Color fundus image.
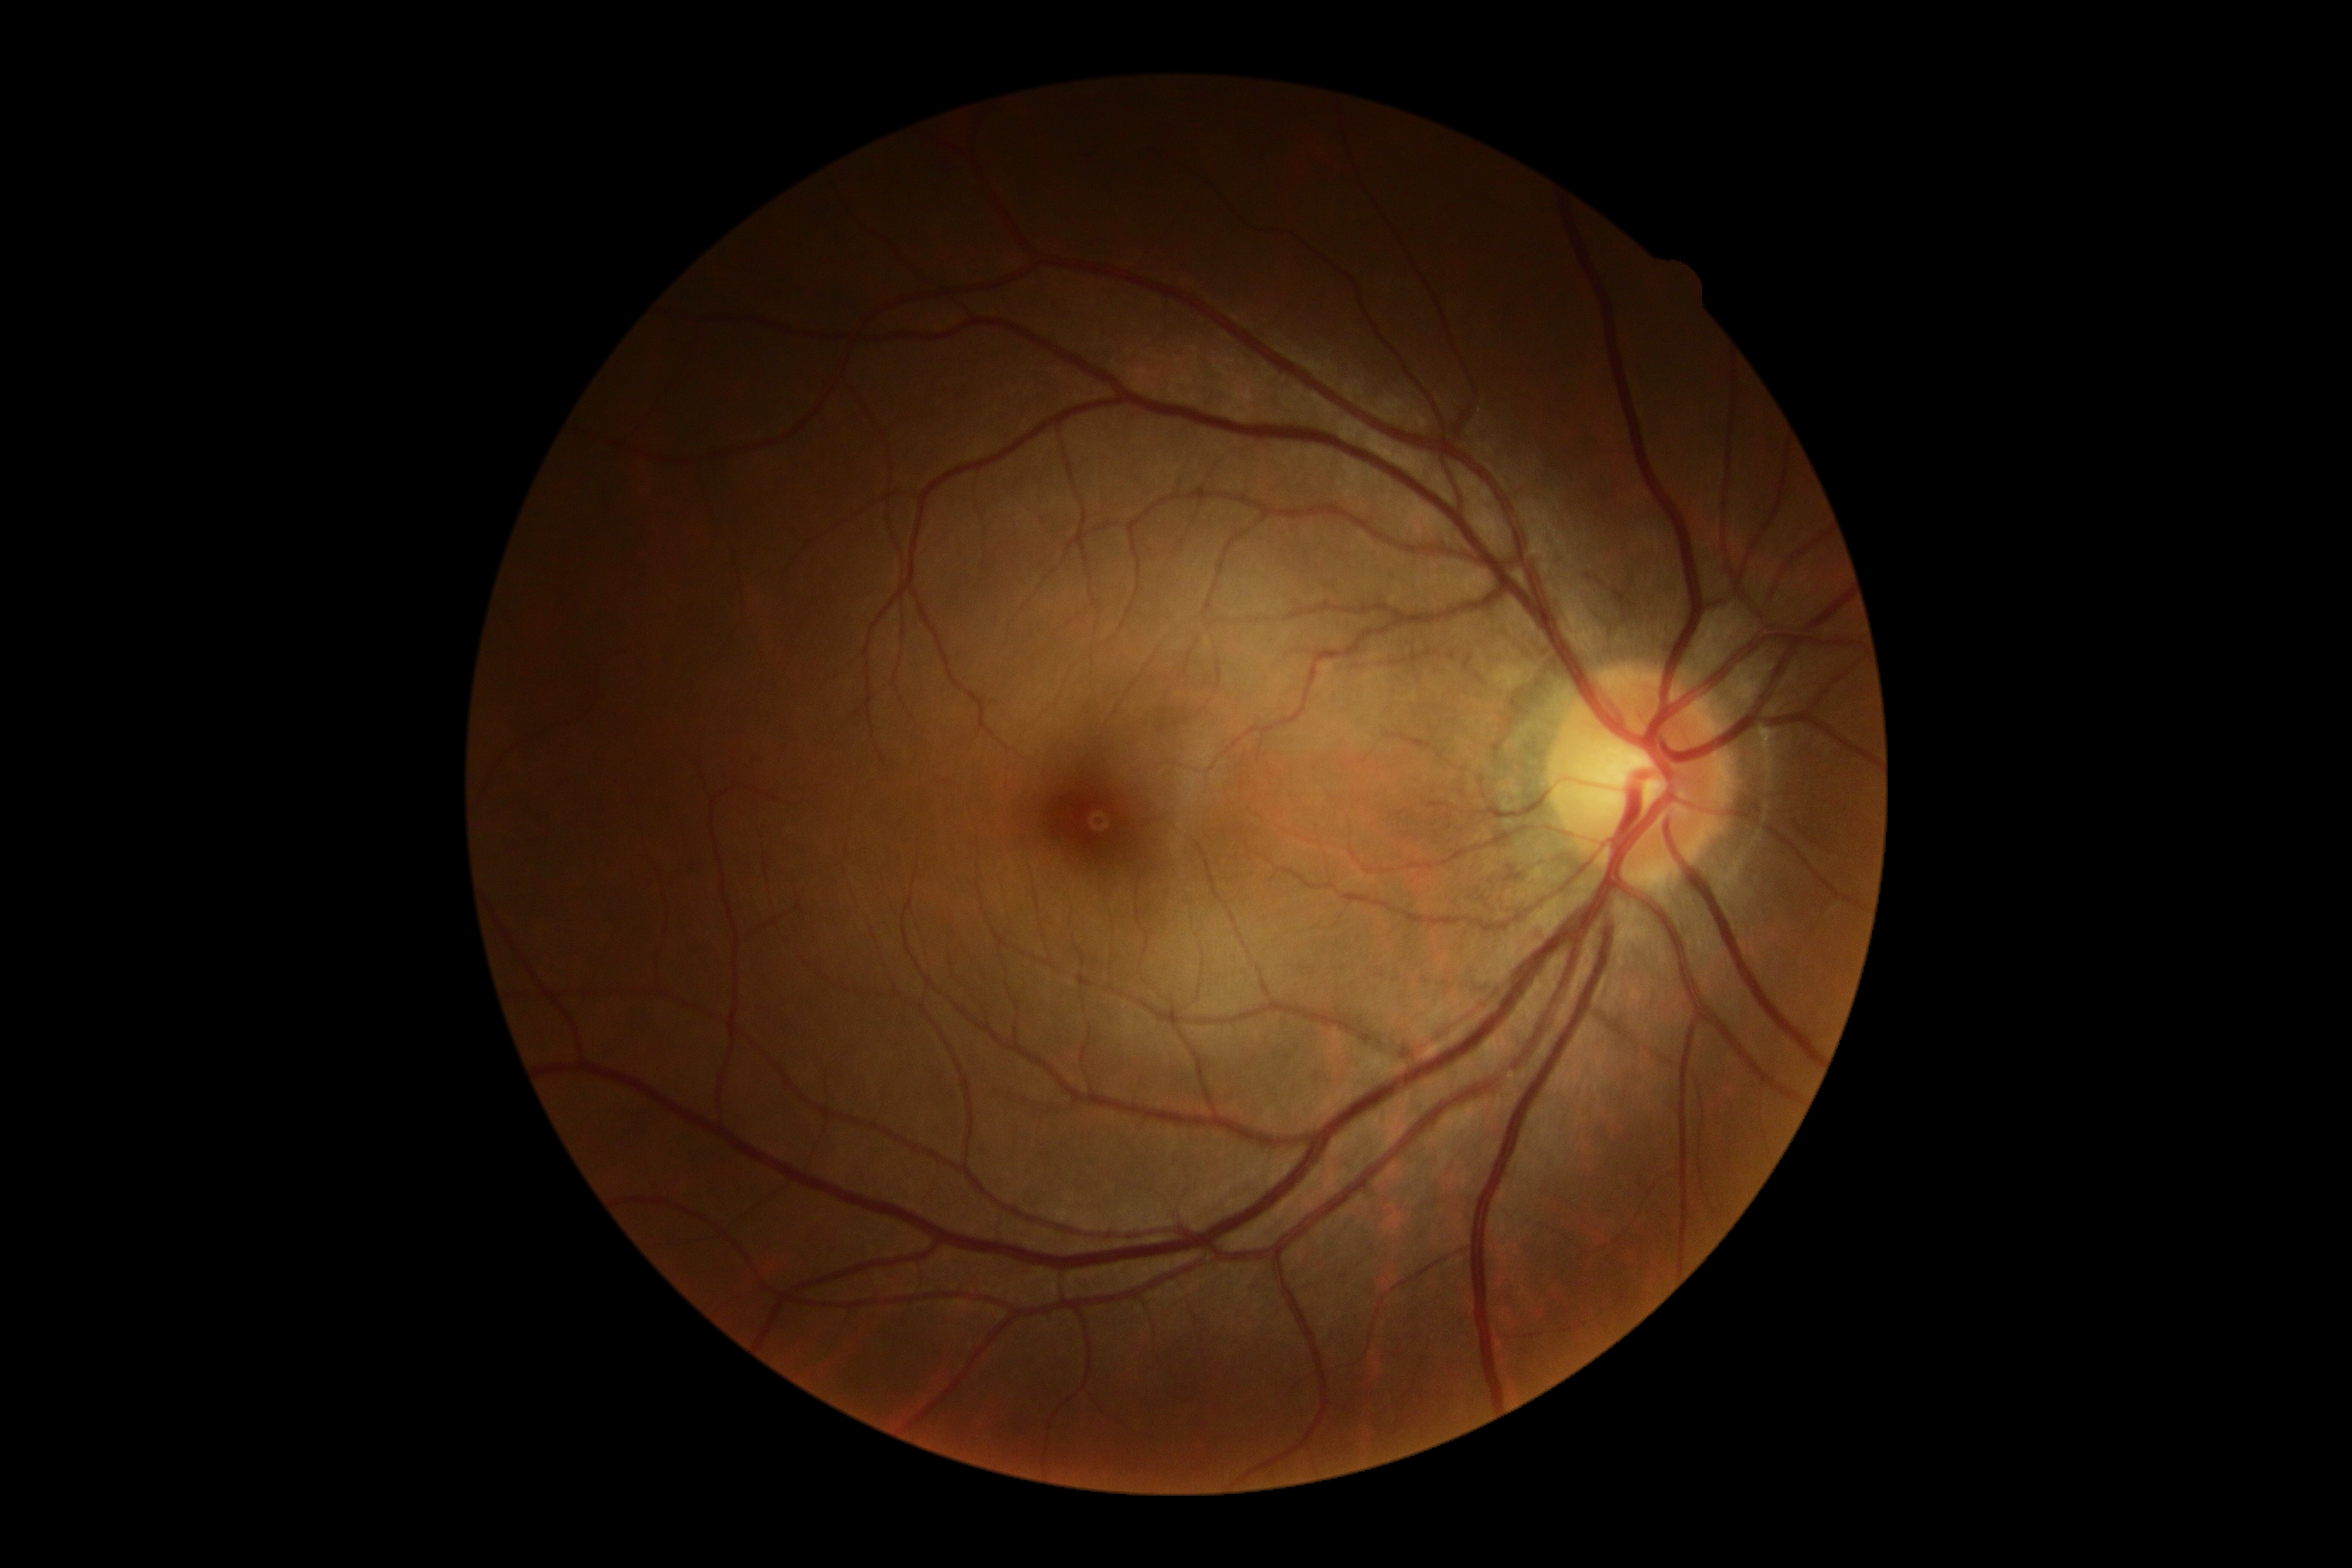

Diabetic retinopathy severity is grade 0 (no apparent retinopathy). No DR findings.